Without pupil dilation; 848 by 848 pixels; posterior pole color fundus photograph; NIDEK AFC-230; 45 degree fundus photograph:
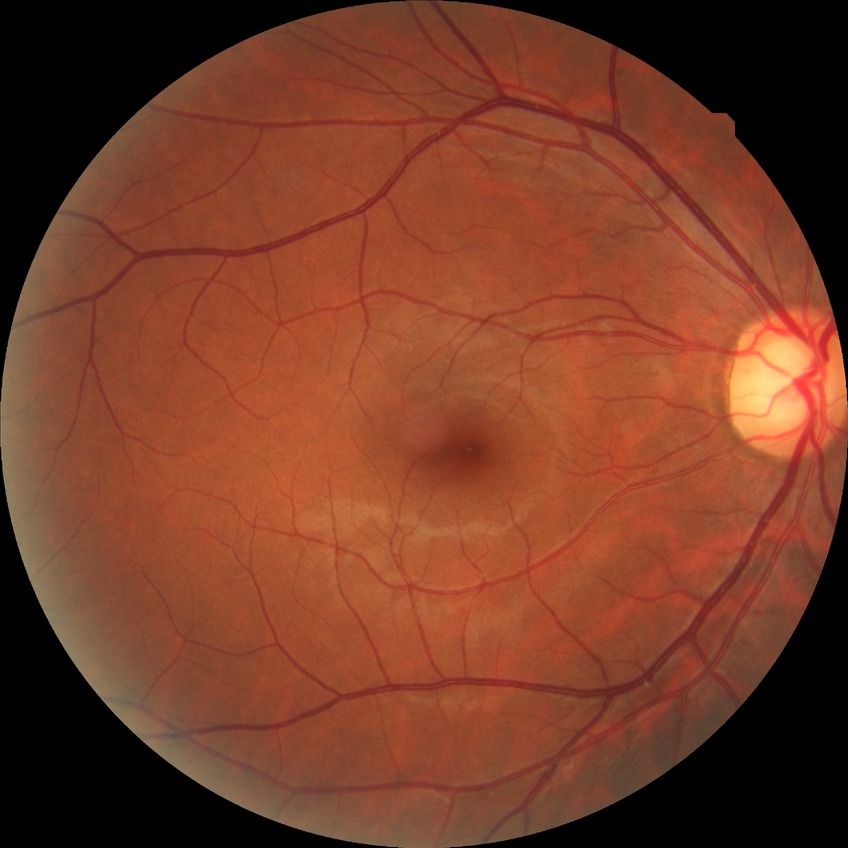
{
  "davis_grade": "NDR"
}